2212x1672, FOV: 45 degrees
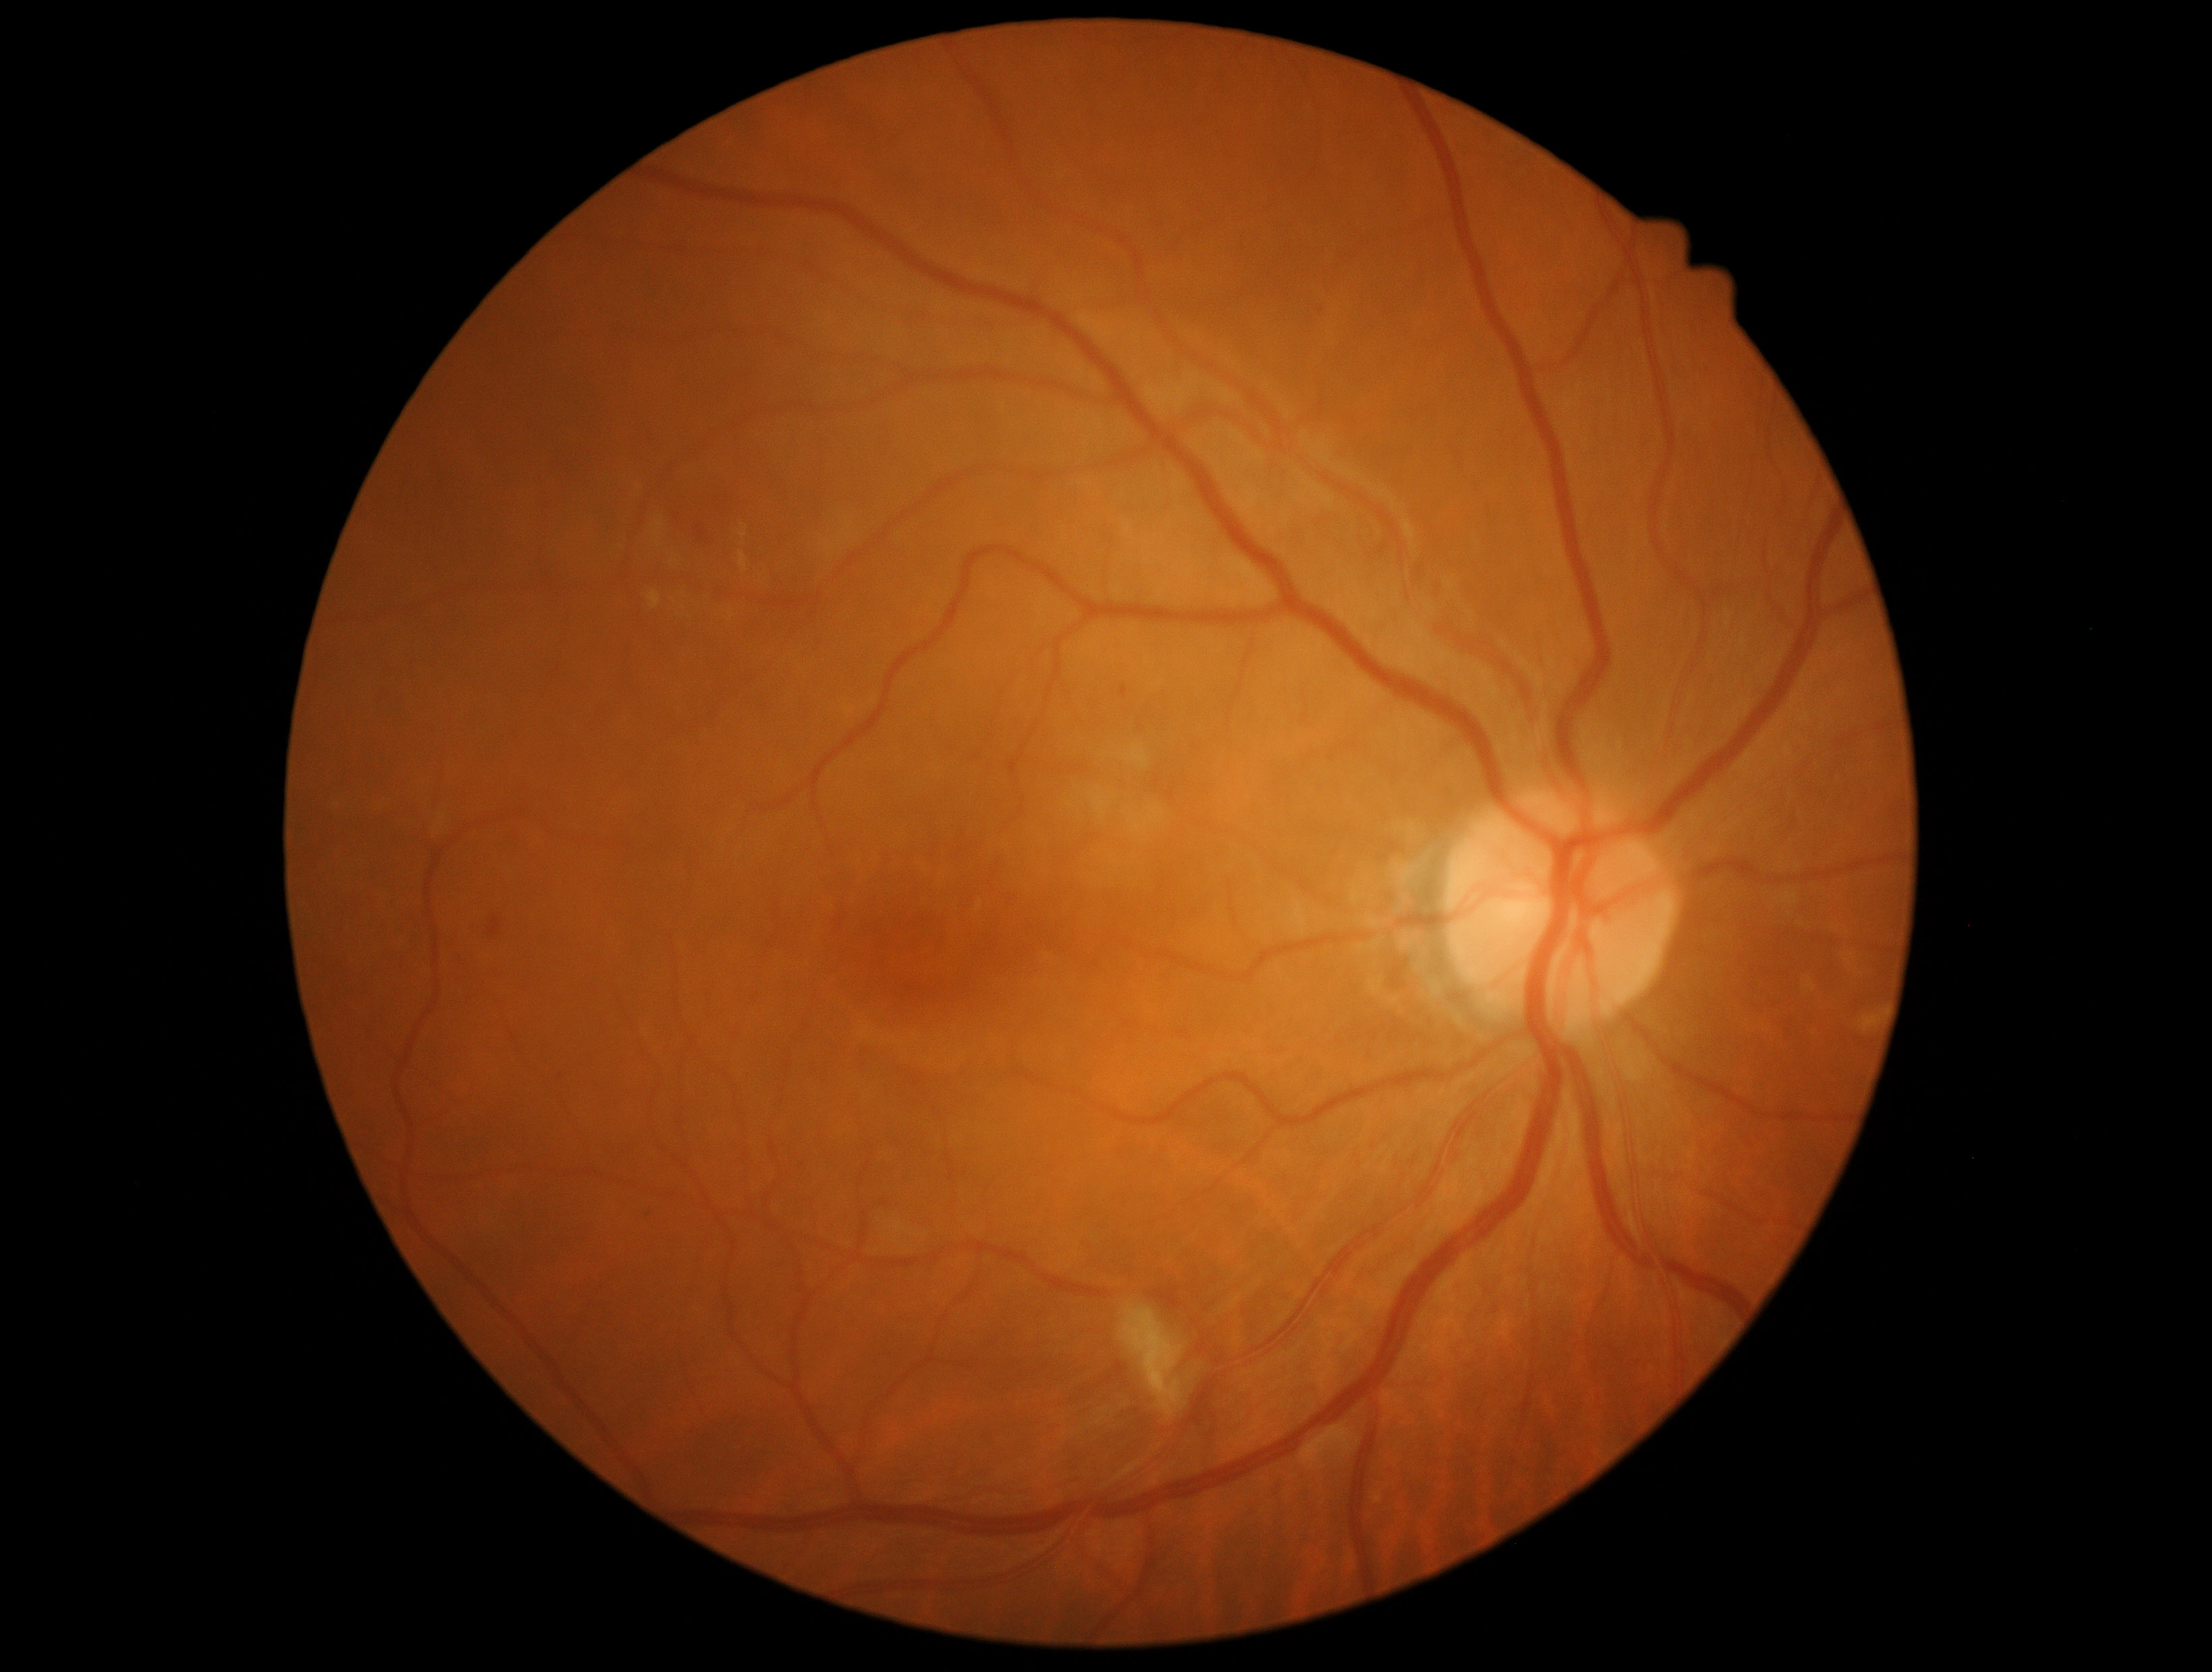 The retinopathy is classified as non-proliferative diabetic retinopathy.
Retinopathy grade: moderate non-proliferative diabetic retinopathy (2) — more than just microaneurysms but less than severe NPDR.